Posterior pole photograph; Davis DR grading; 848x848px — 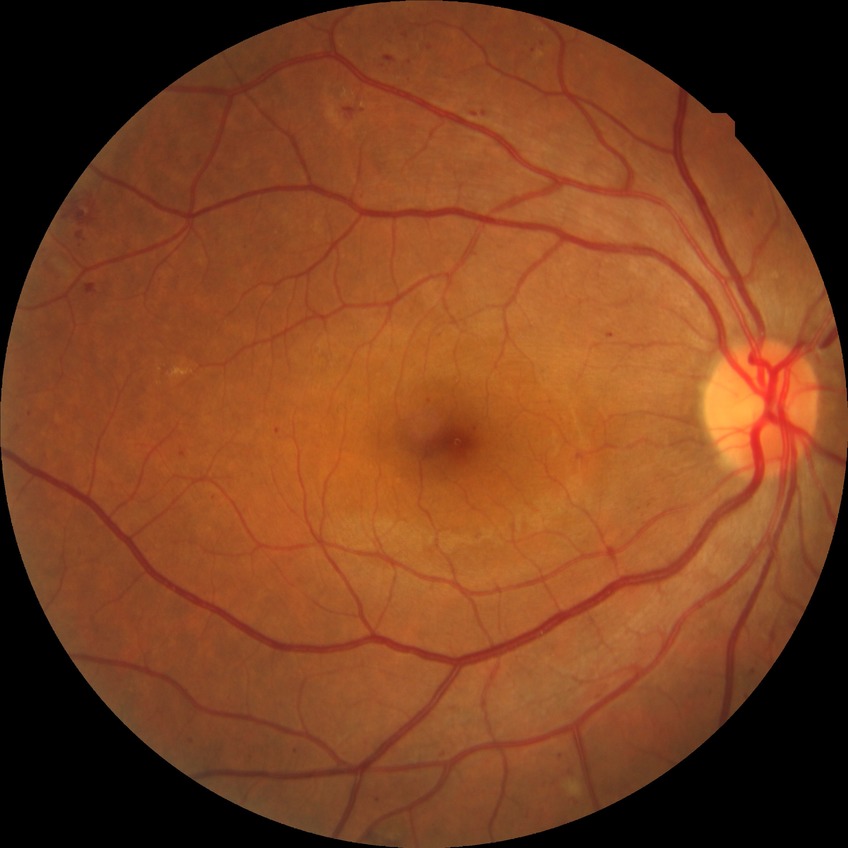 DR class = non-proliferative diabetic retinopathy
diabetic retinopathy (DR) = simple diabetic retinopathy (SDR)